Retinal fundus photograph:
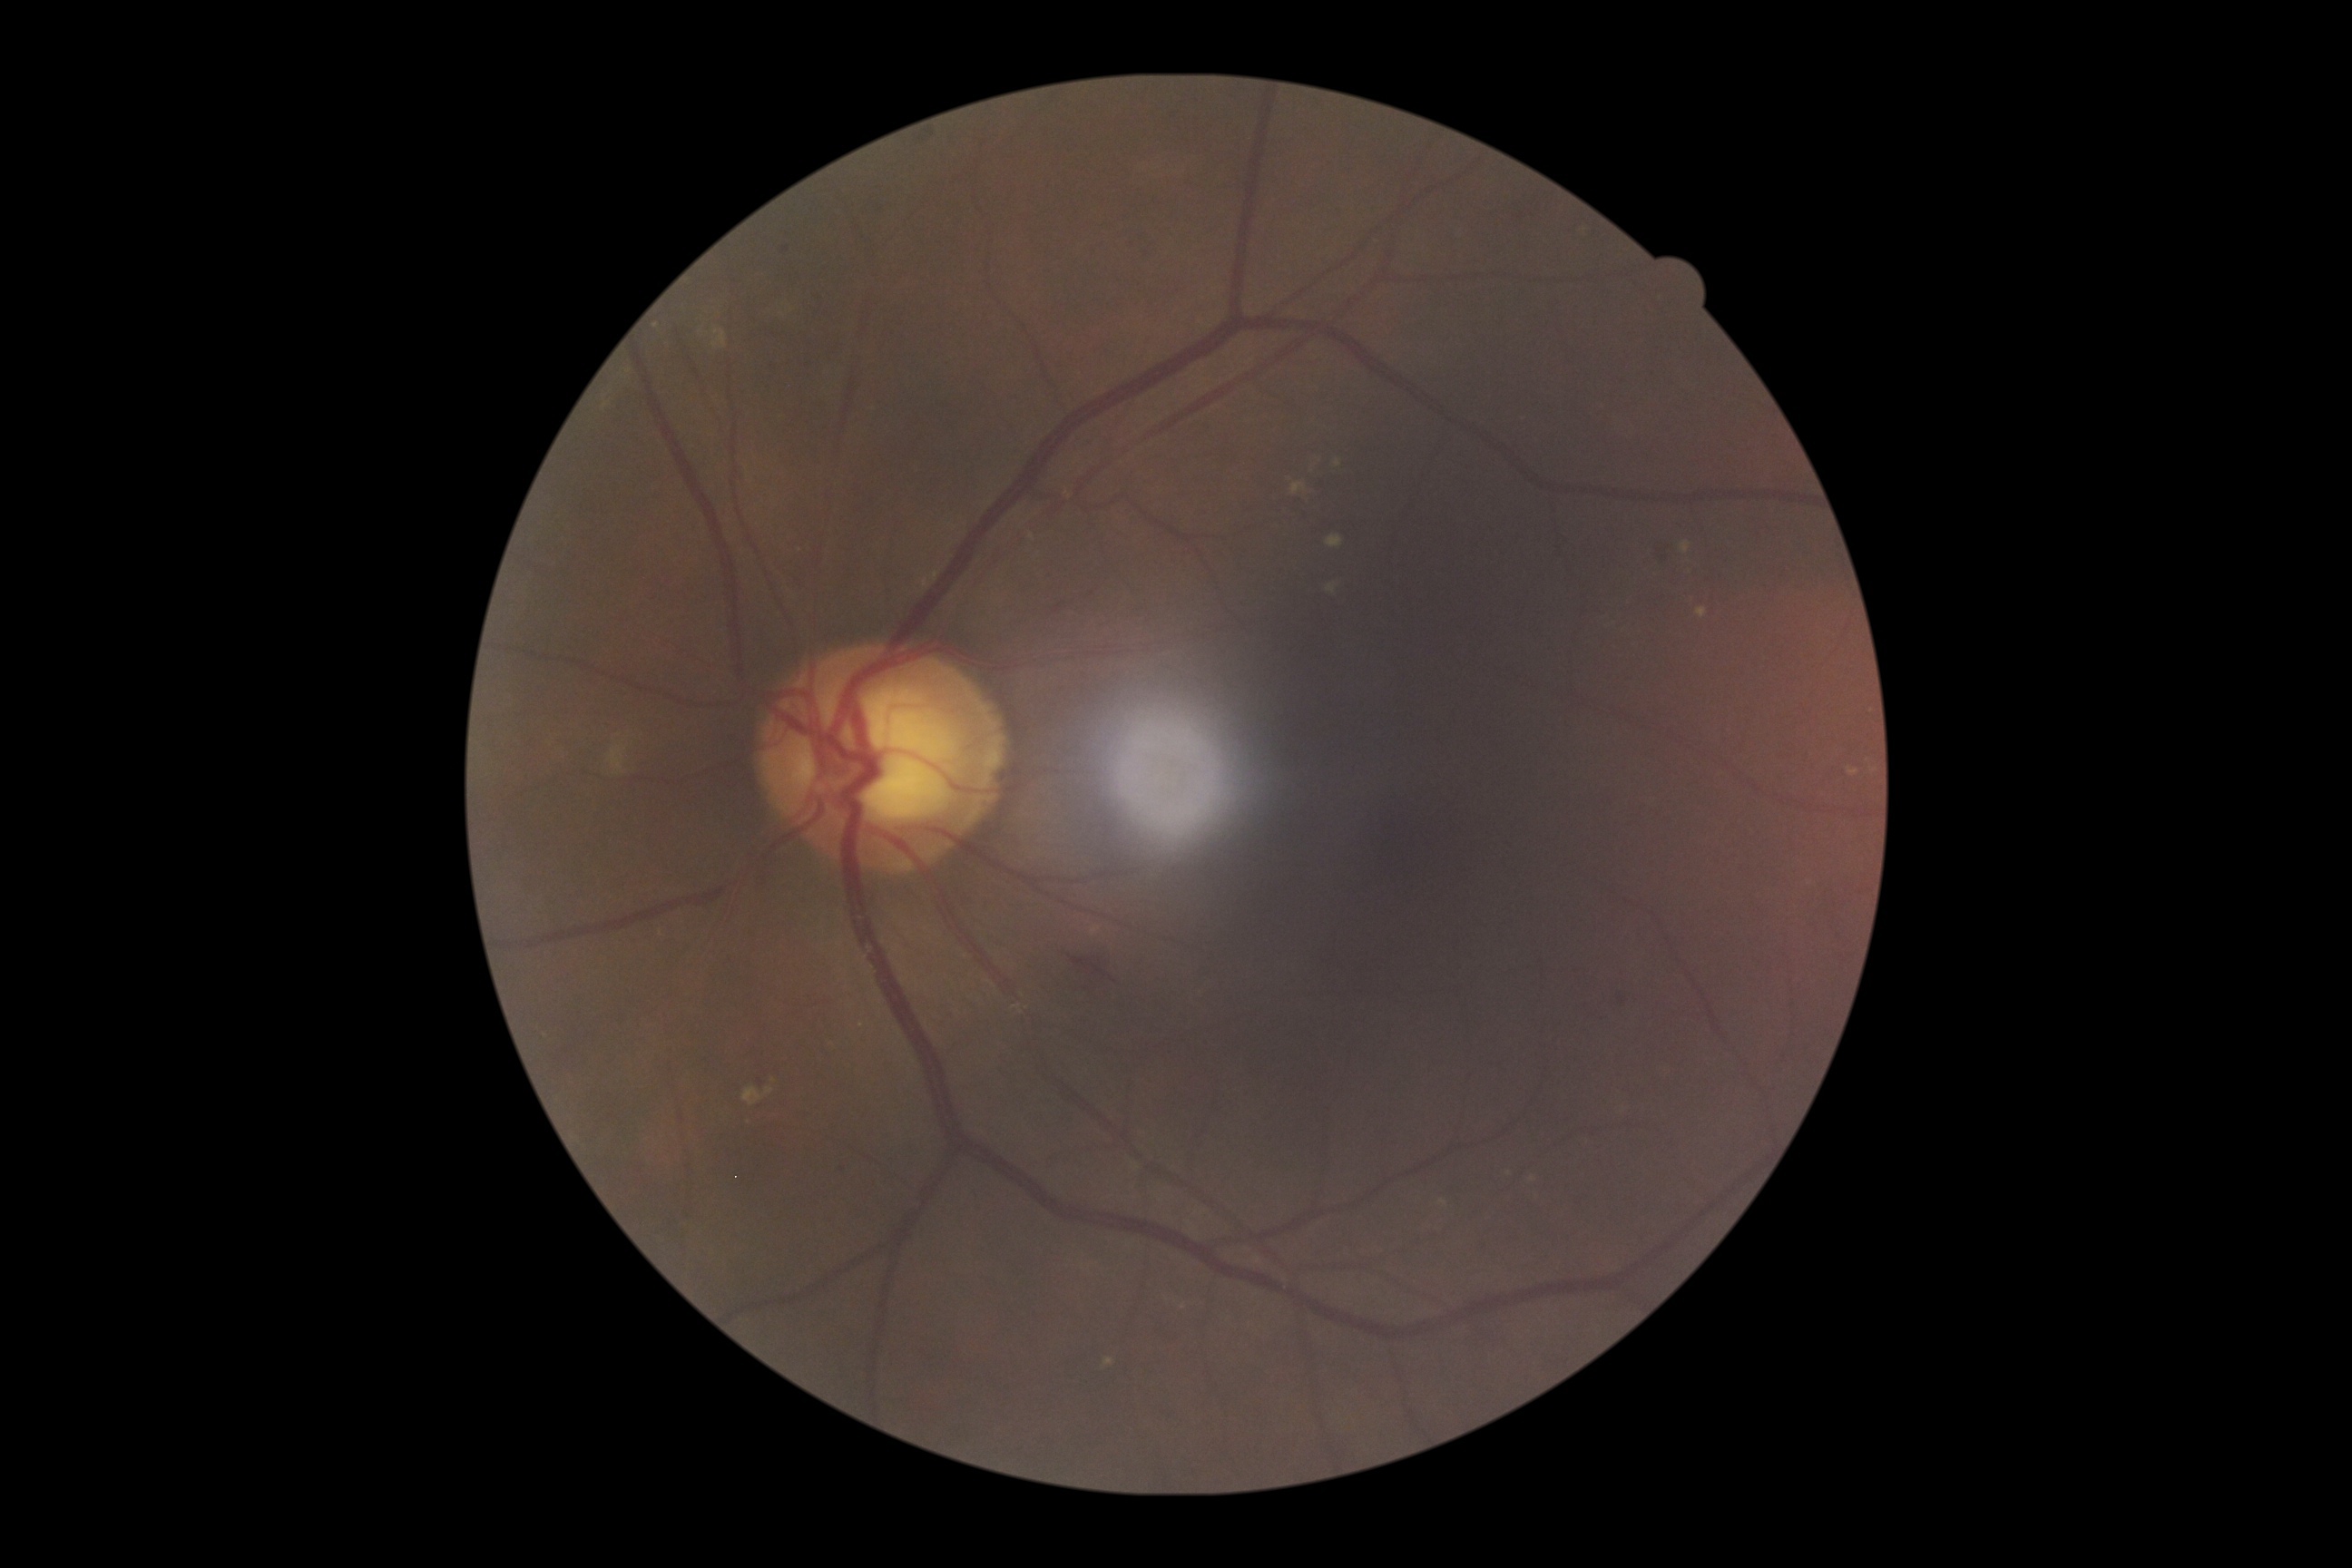 DR is grade 2 (moderate NPDR) — more than just microaneurysms but less than severe NPDR.
The retinopathy is classified as non-proliferative diabetic retinopathy.